45° field of view:
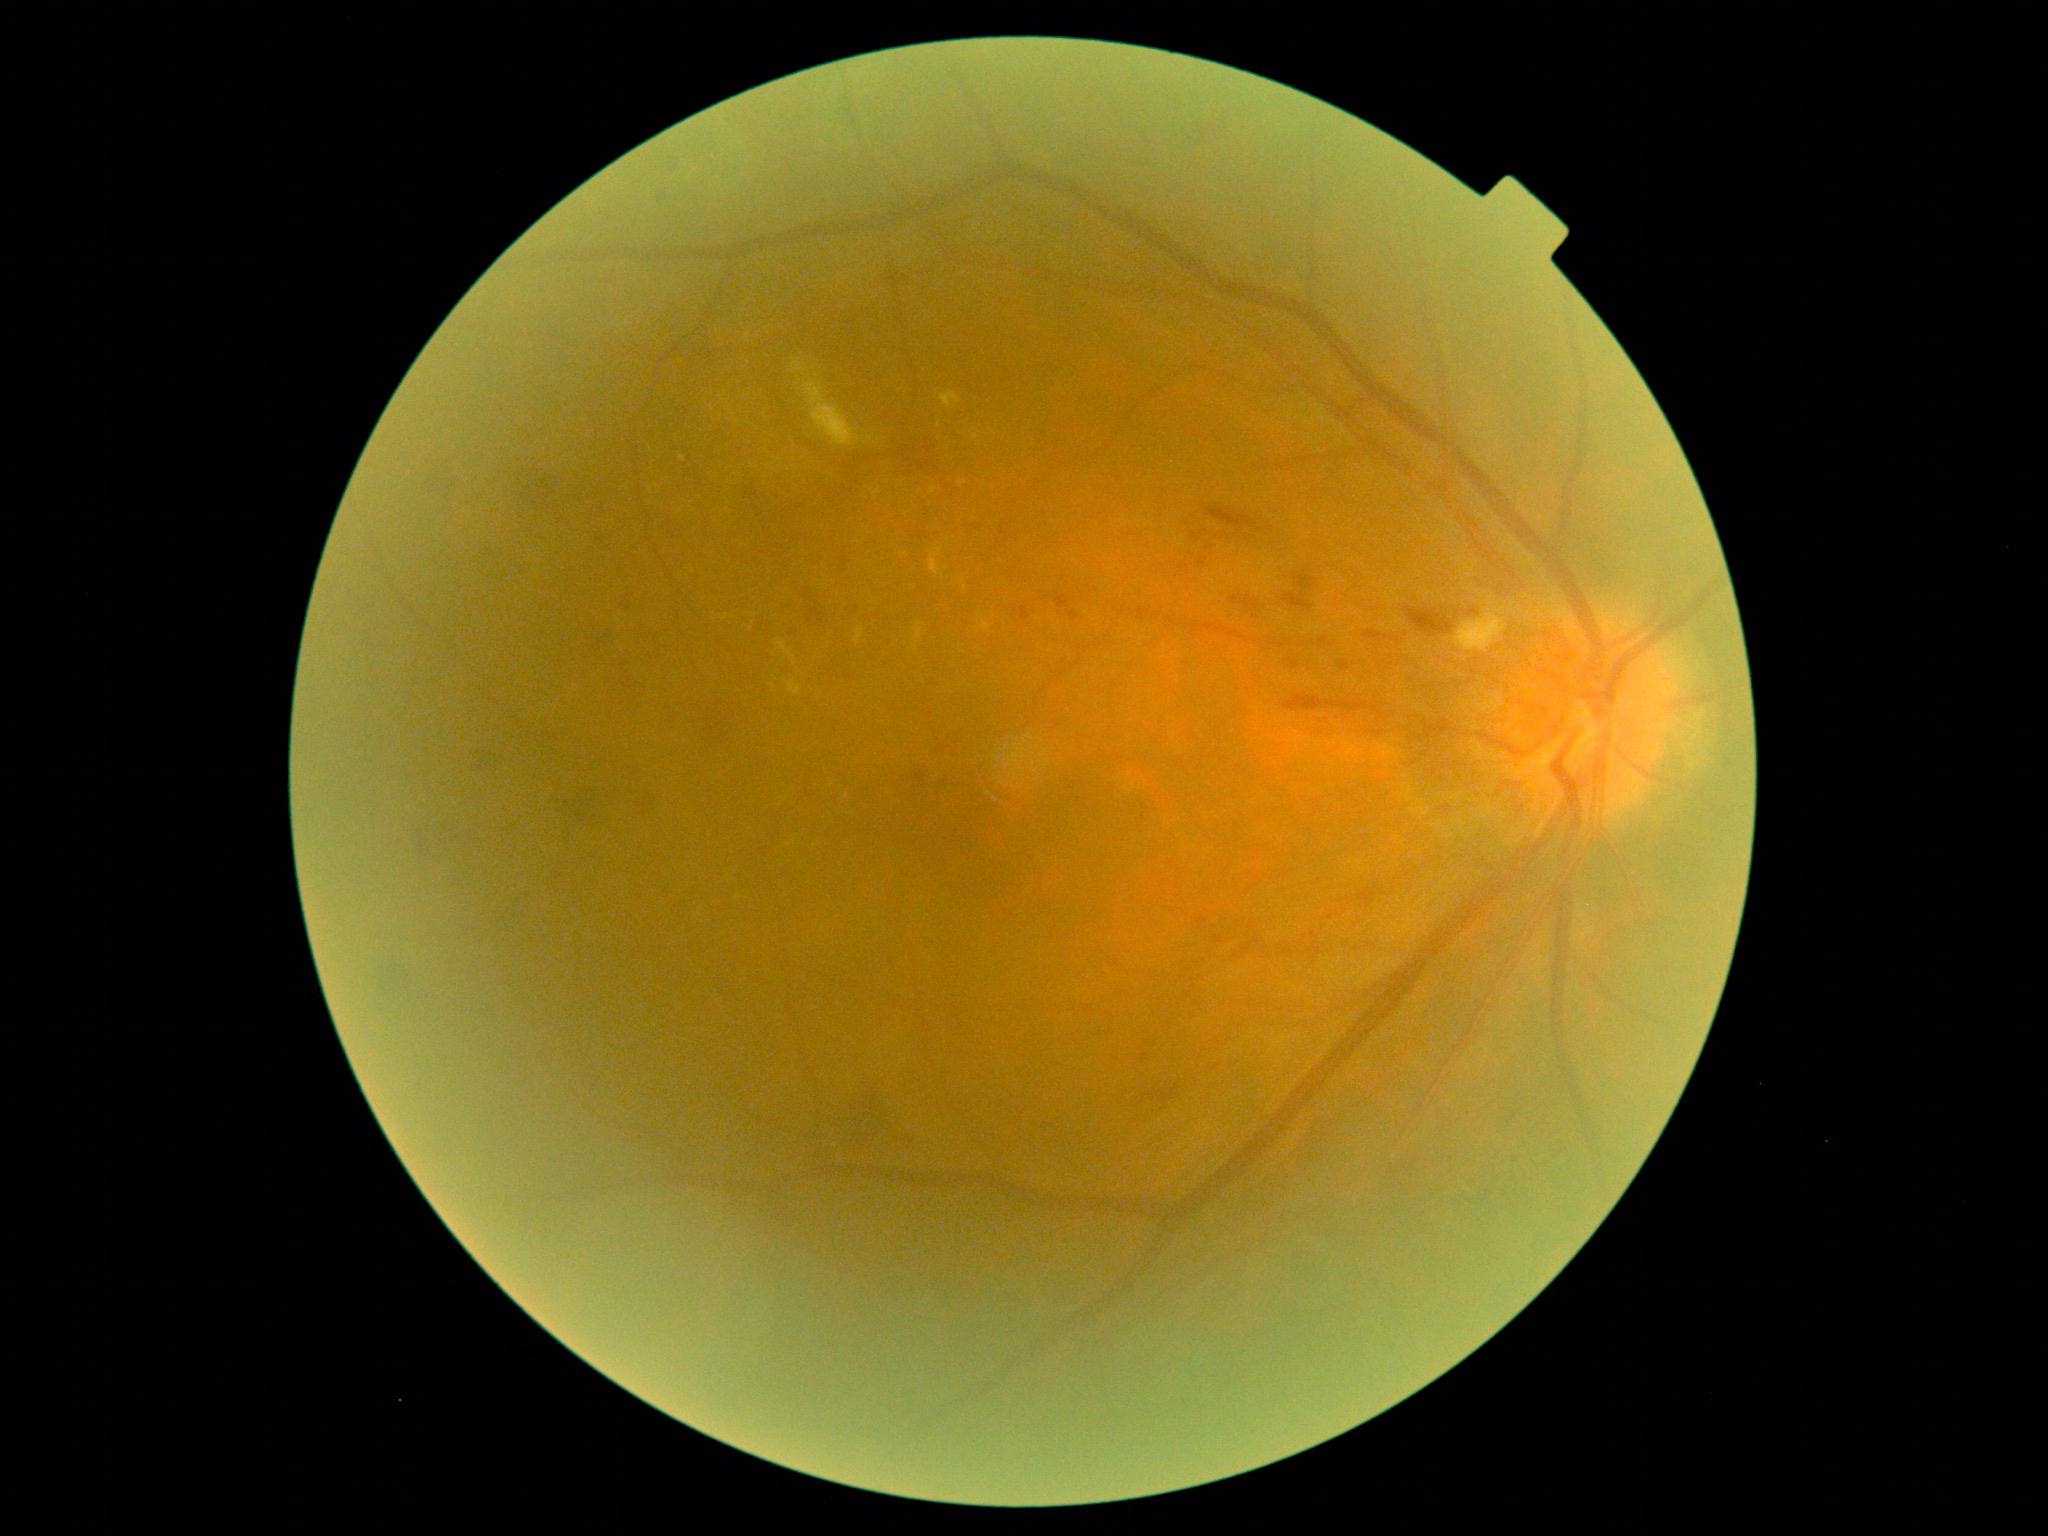 diabetic retinopathy (DR)@2.